Color fundus image, FOV: 45 degrees.
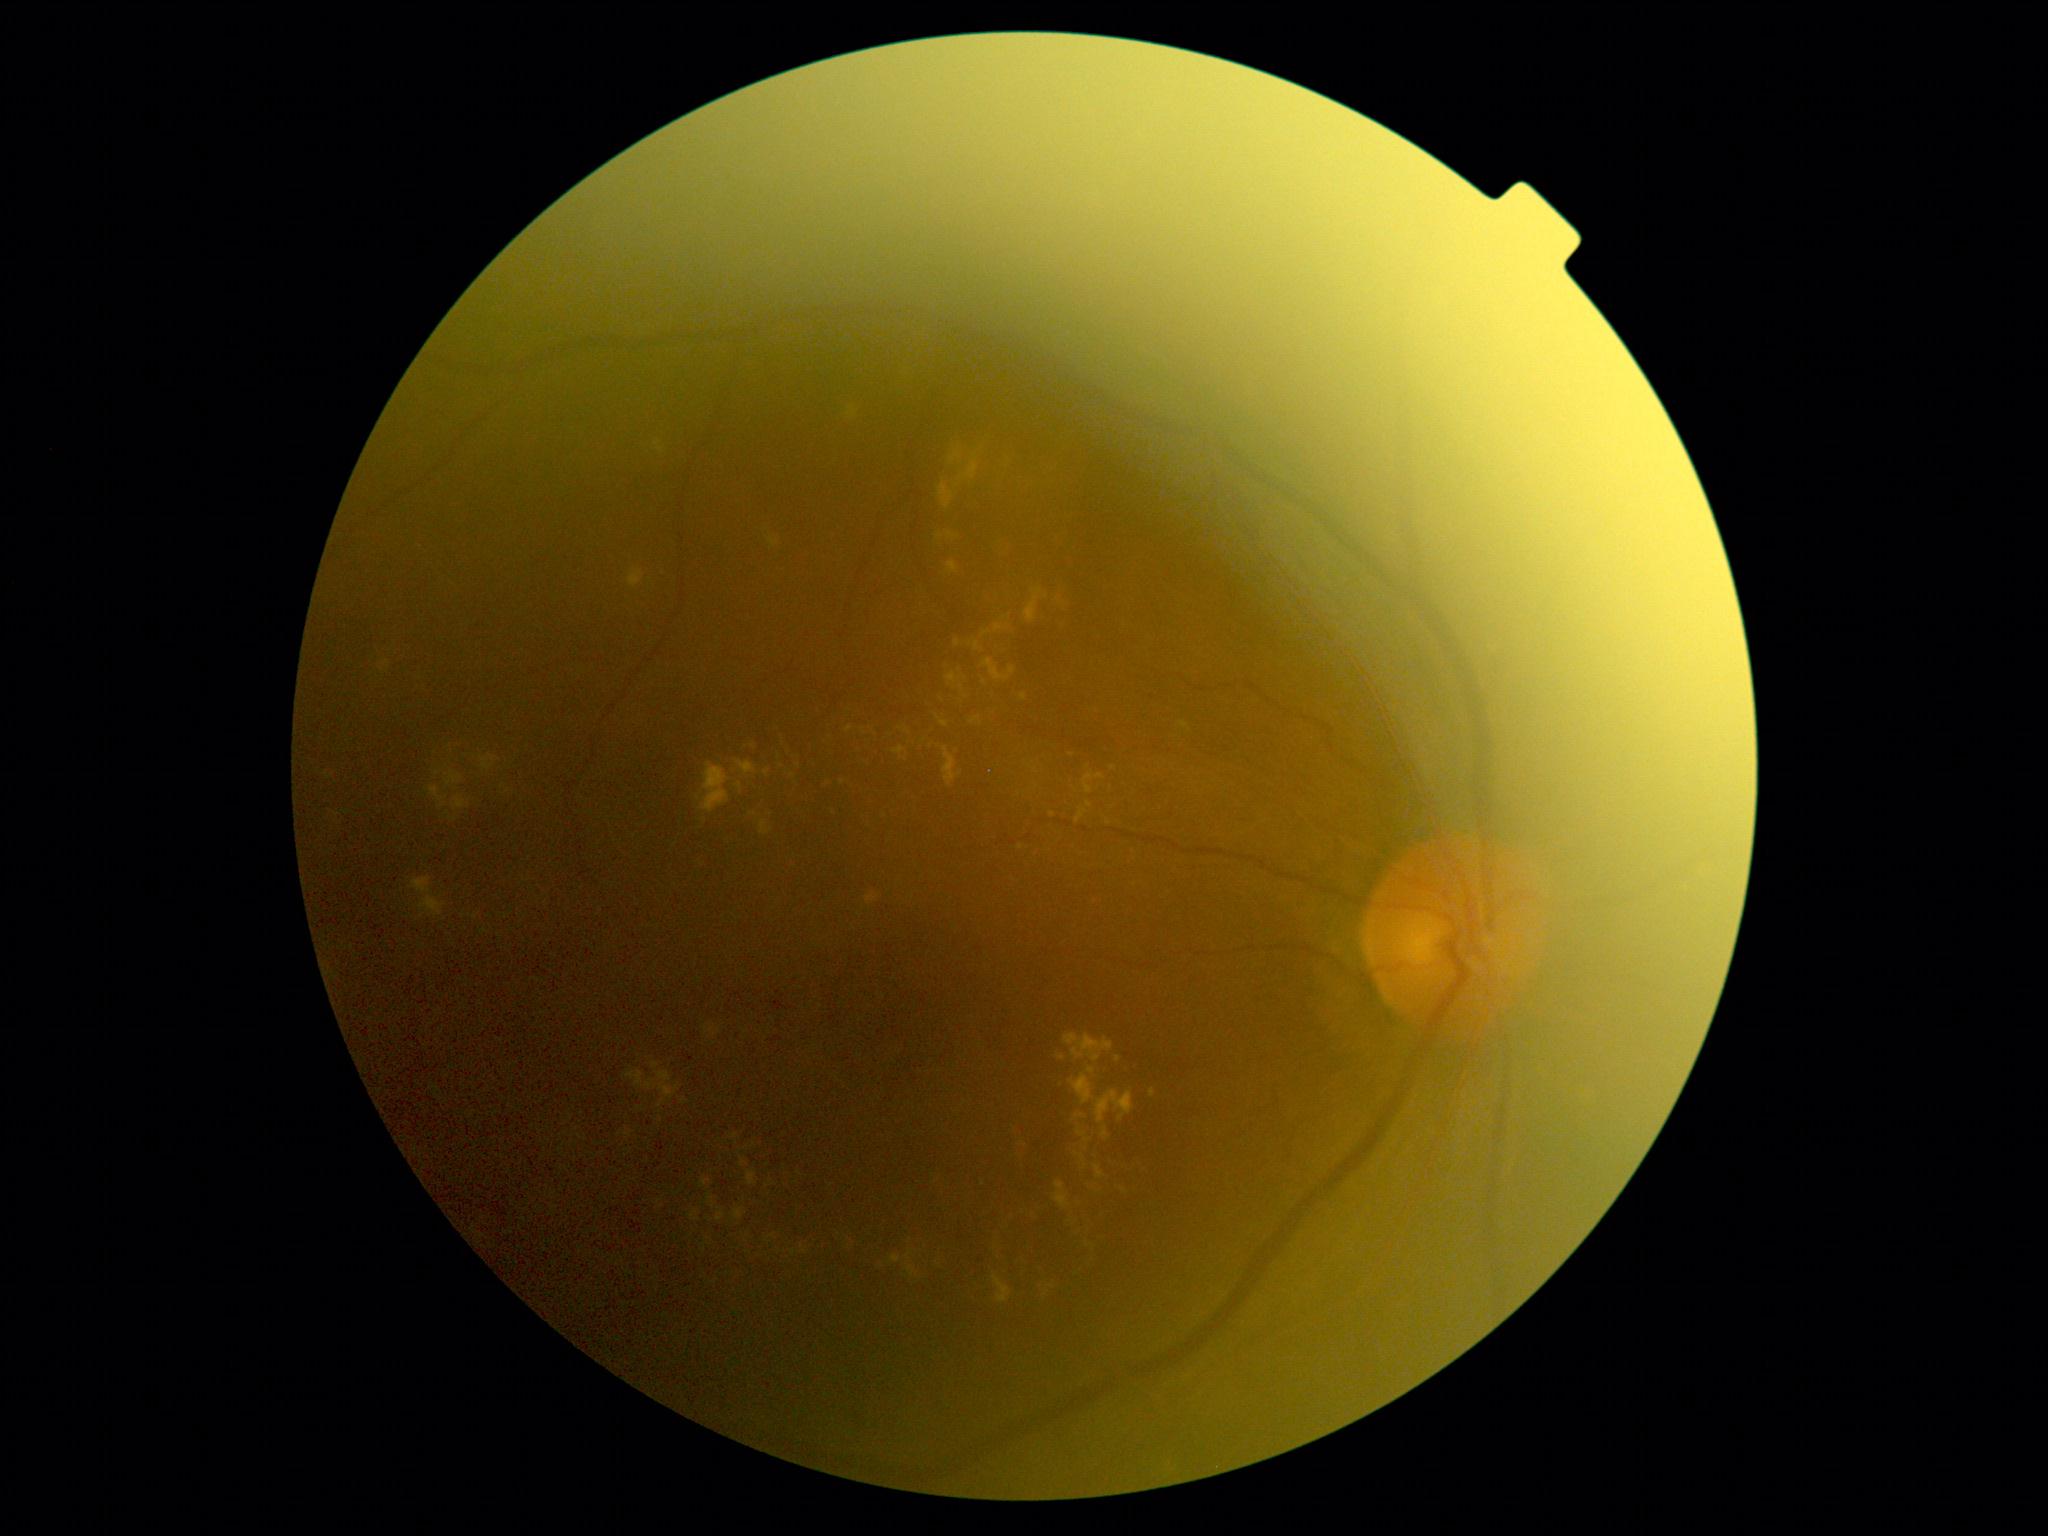
DR grade is 2
Representative lesions:
EXs (partial): (890, 1256, 900, 1264); (425, 786, 449, 809); (992, 1211, 1009, 1270); (1075, 809, 1088, 824); (731, 1134, 739, 1140); (996, 535, 1008, 560); (747, 1171, 757, 1187); (700, 763, 731, 813); (658, 1100, 667, 1108); (802, 1246, 807, 1254); (939, 484, 955, 509); (1009, 667, 1016, 676); (848, 406, 857, 418); (717, 1208, 726, 1221)
Additional small EXs near (754, 1145); (1123, 1190); (1089, 805); (1008, 617); (794, 775); (1072, 755)